NIDEK AFC-230 fundus camera, color fundus image, 848x848, diabetic retinopathy graded by the modified Davis classification.
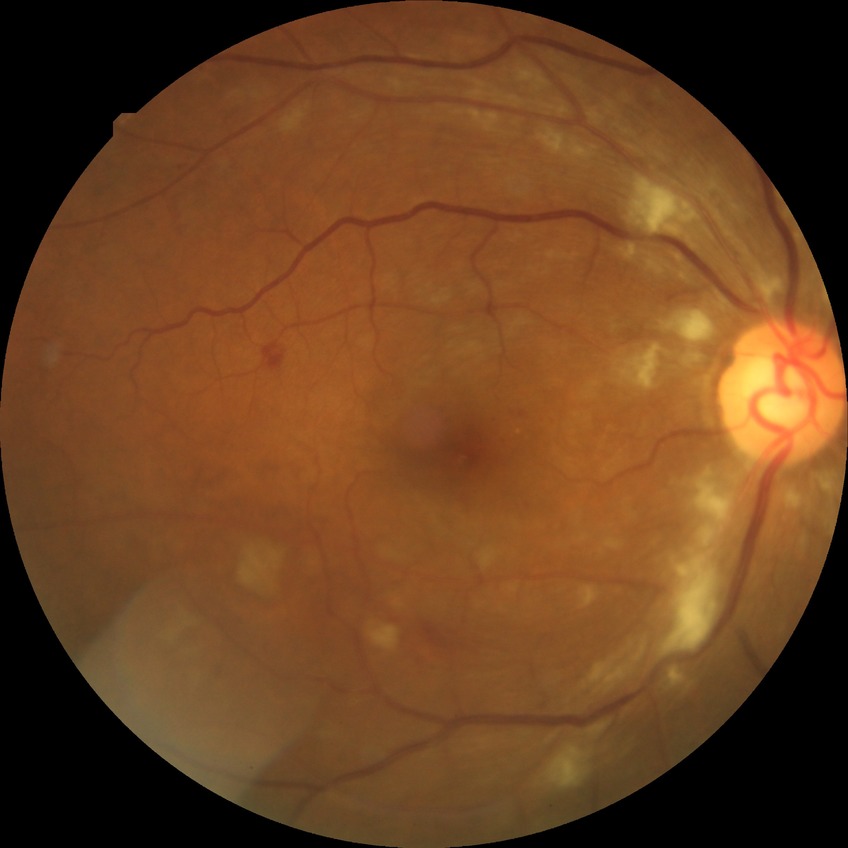 Diabetic retinopathy (DR) is pre-proliferative diabetic retinopathy (PPDR).